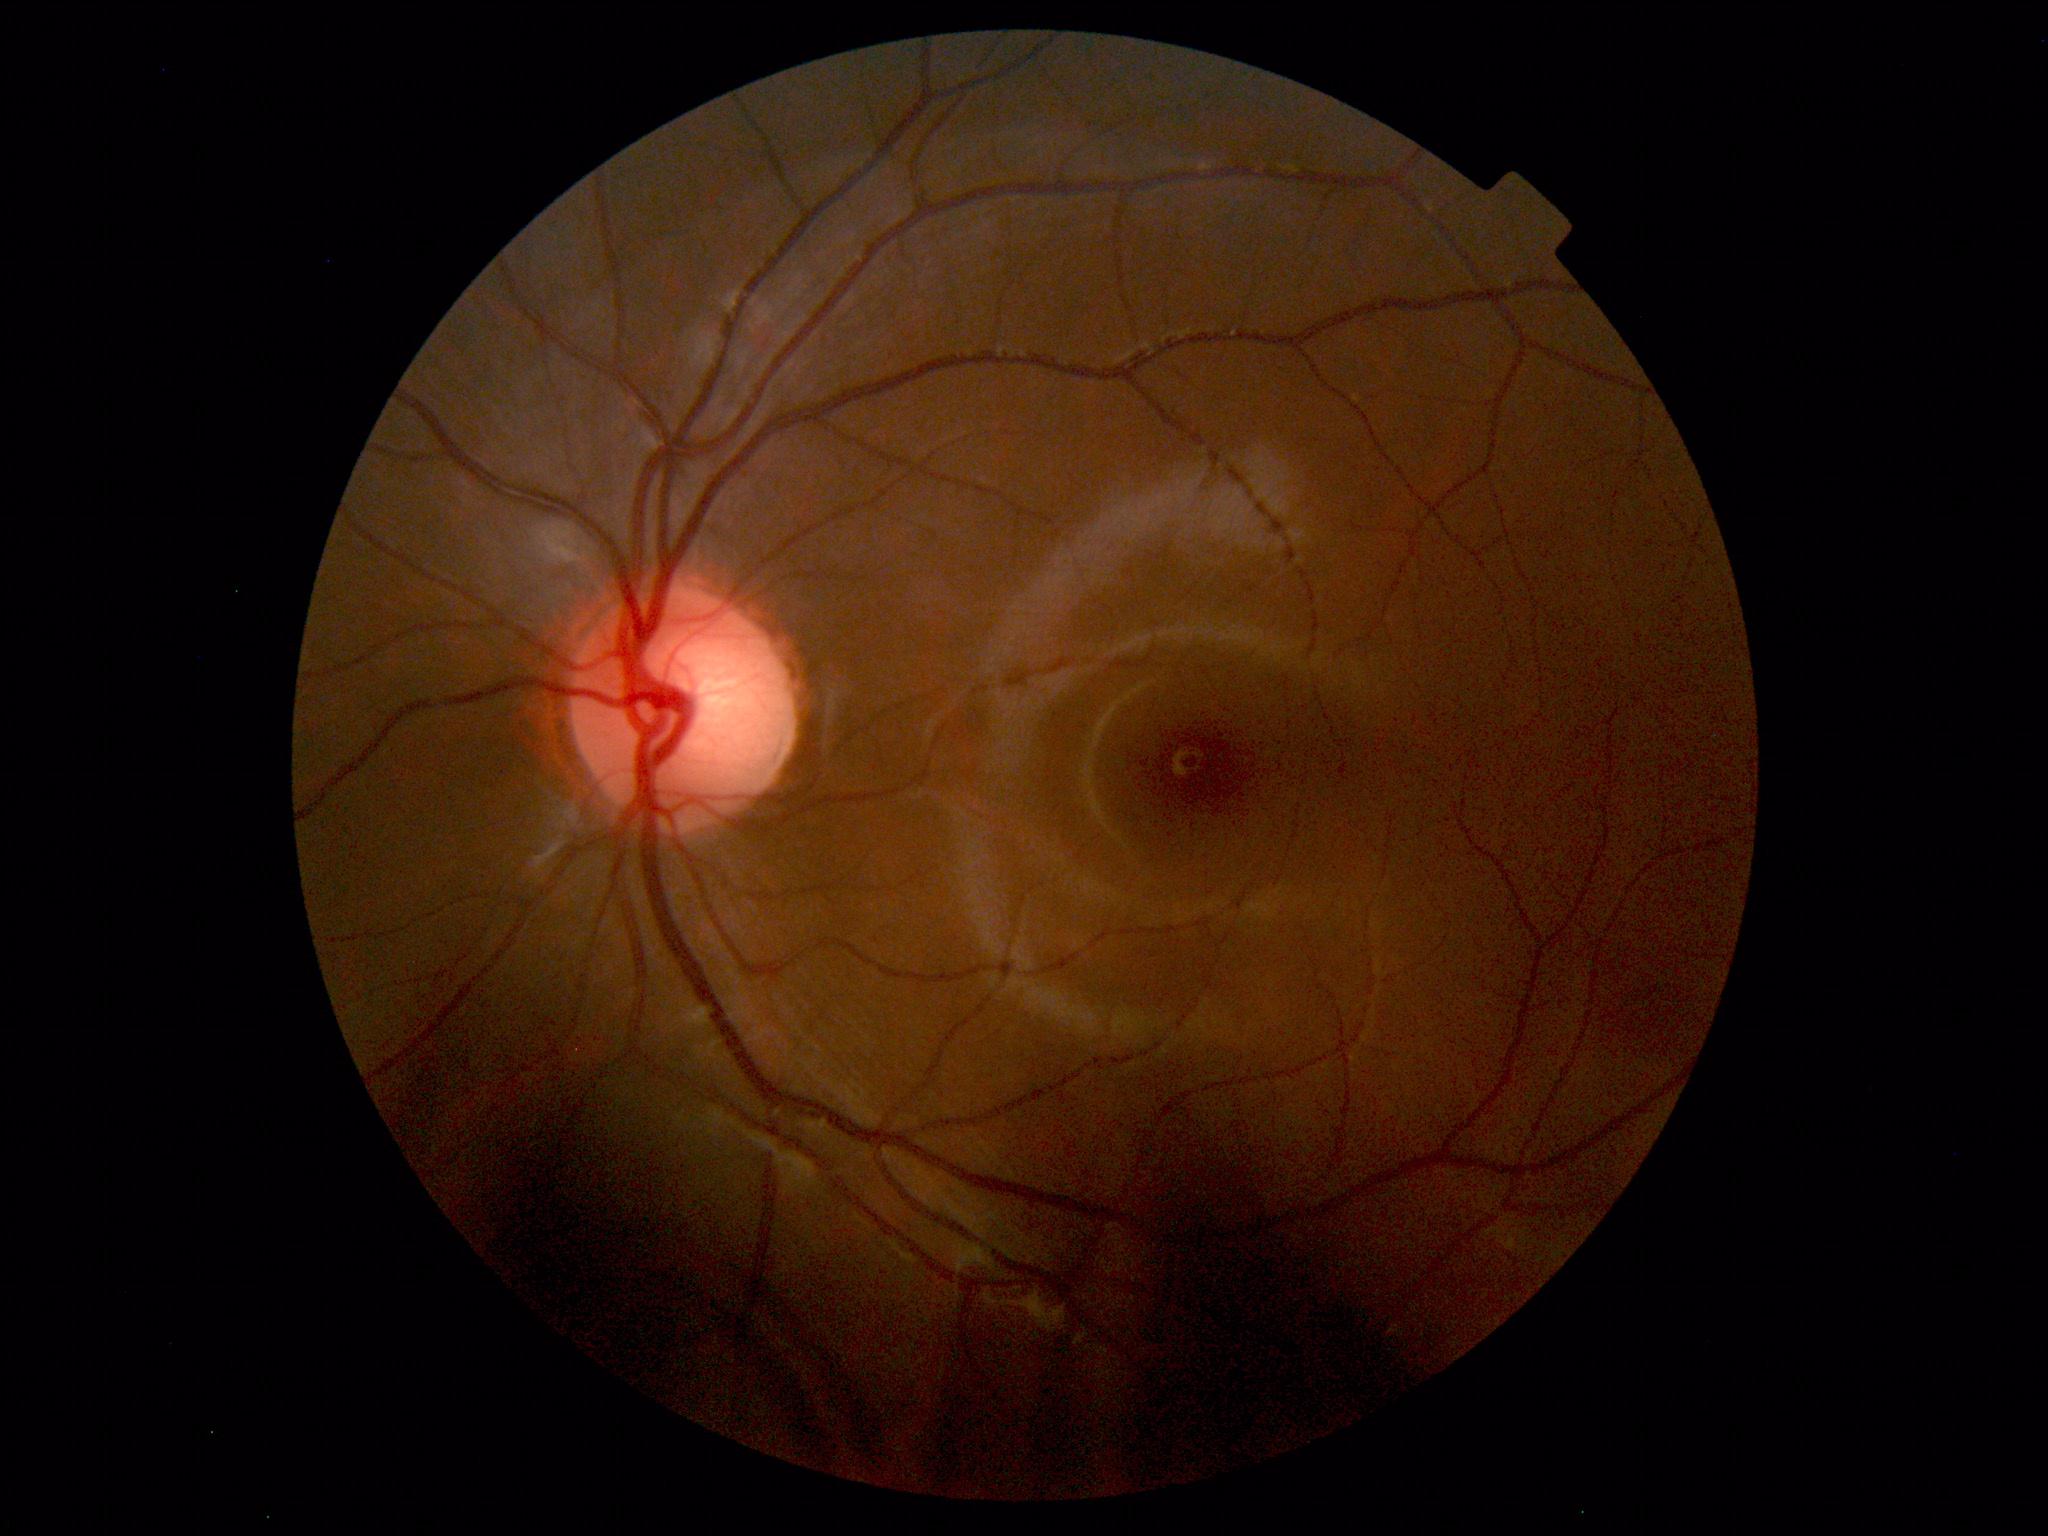
No abnormal findings on fundus examination.